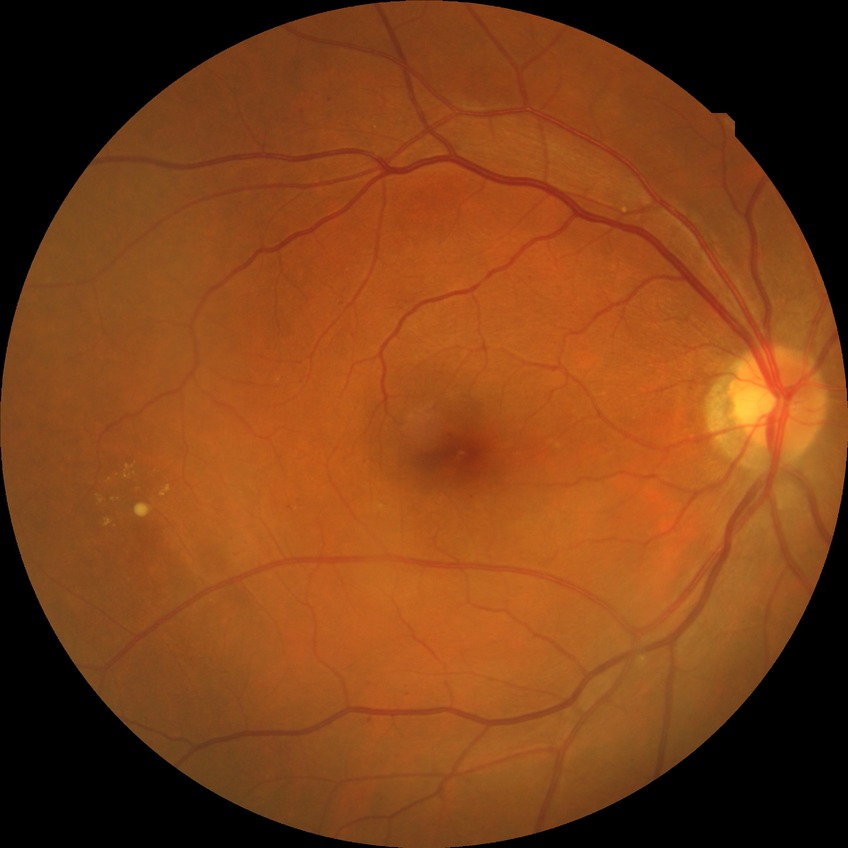

retinopathy stage@simple diabetic retinopathy.